CFP · acquired with a Bosch handheld fundus camera.
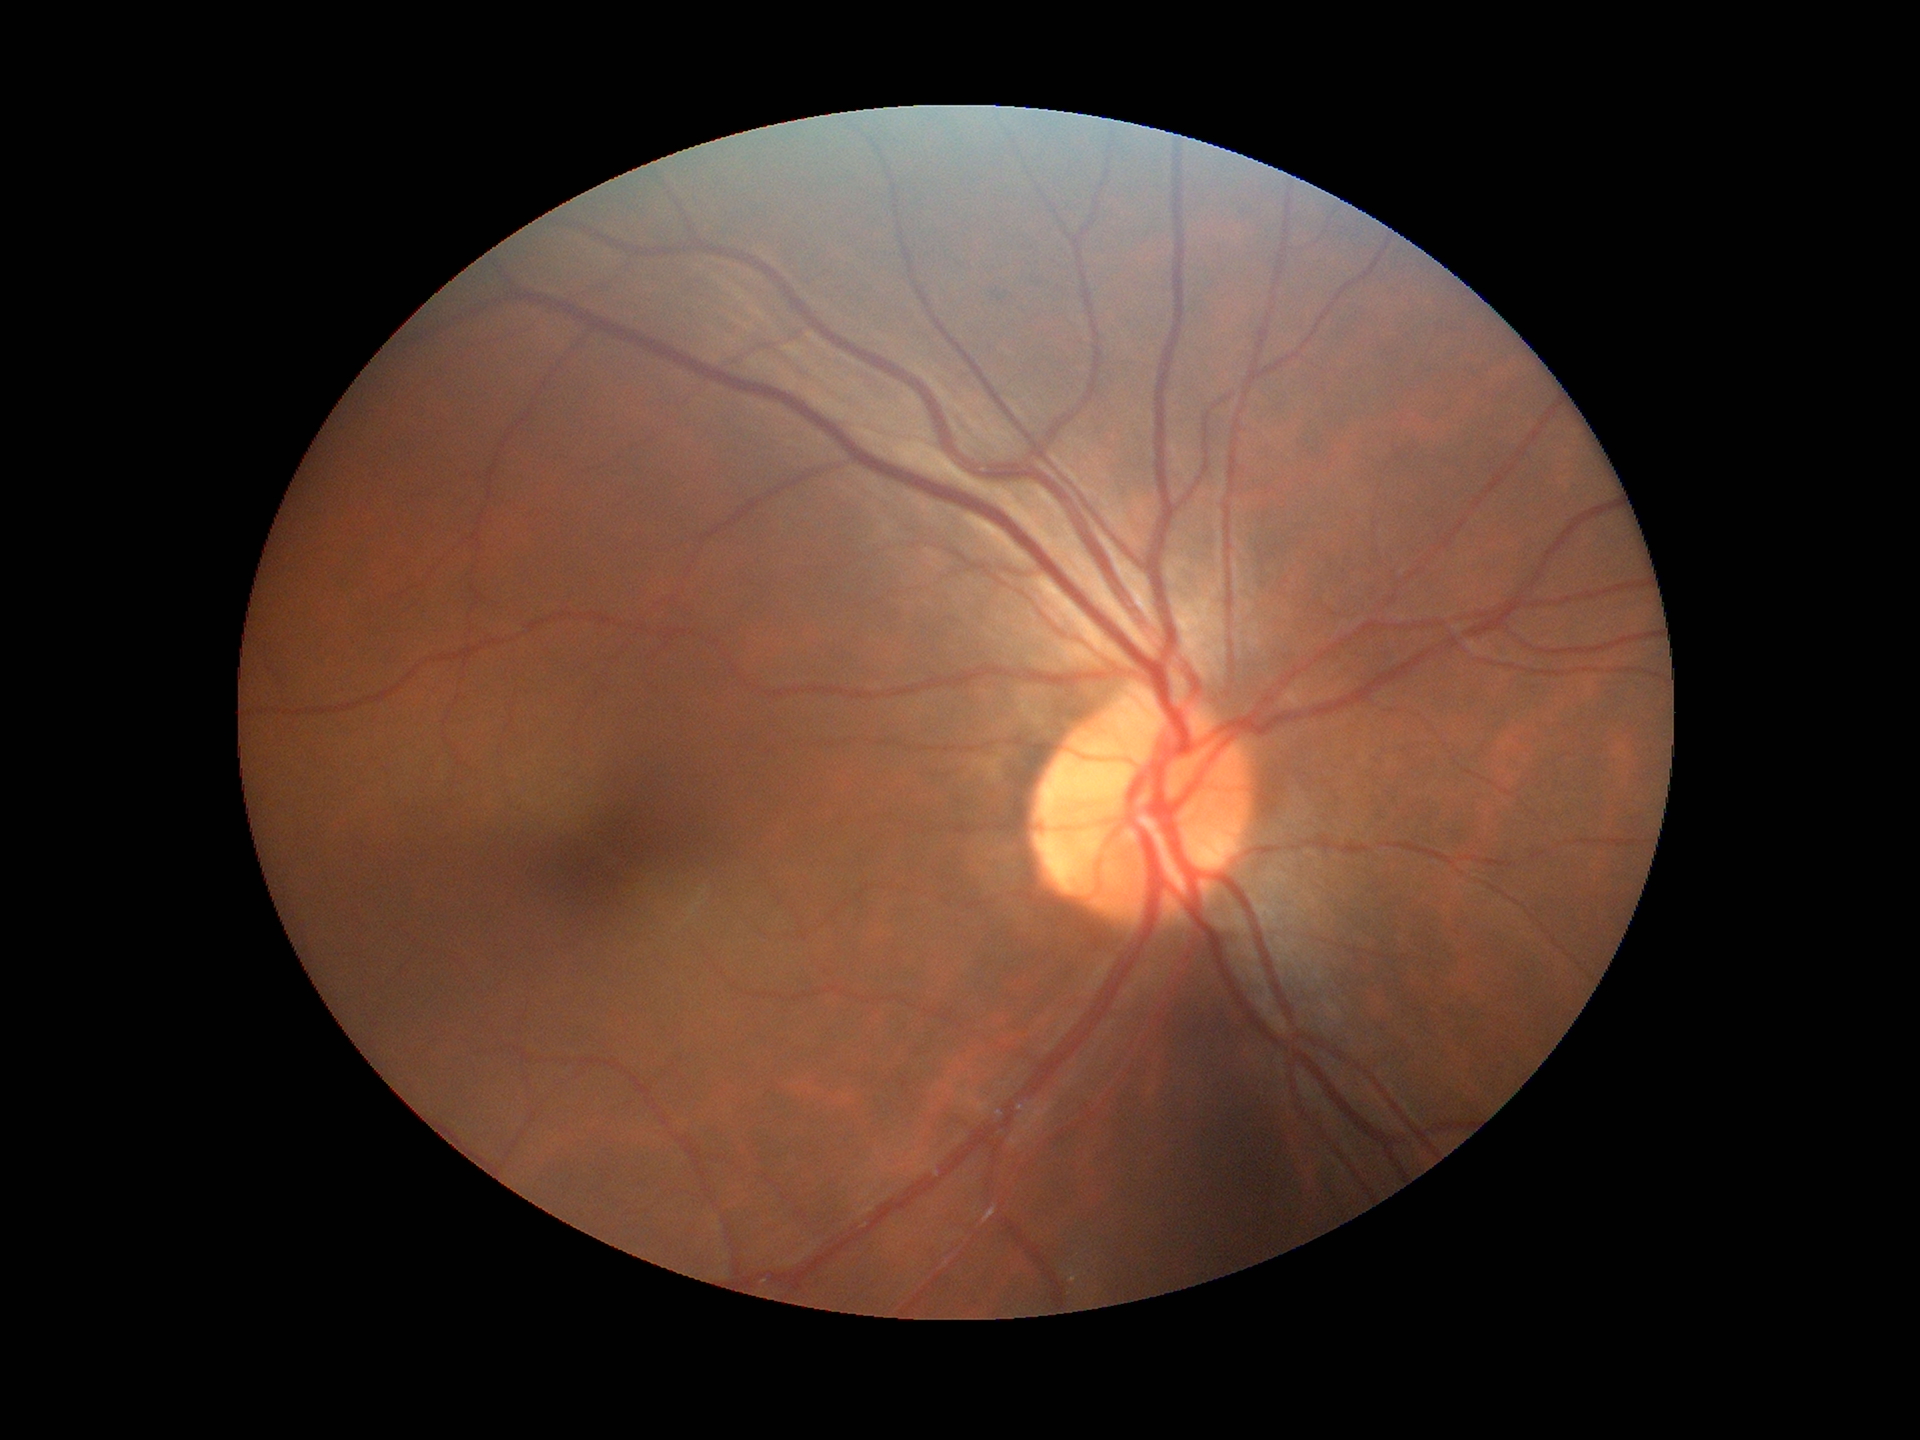
Glaucoma decision=not suspect
vertical CDR (VCDR)=0.45
area cup-to-disc ratio (ACDR)=0.20